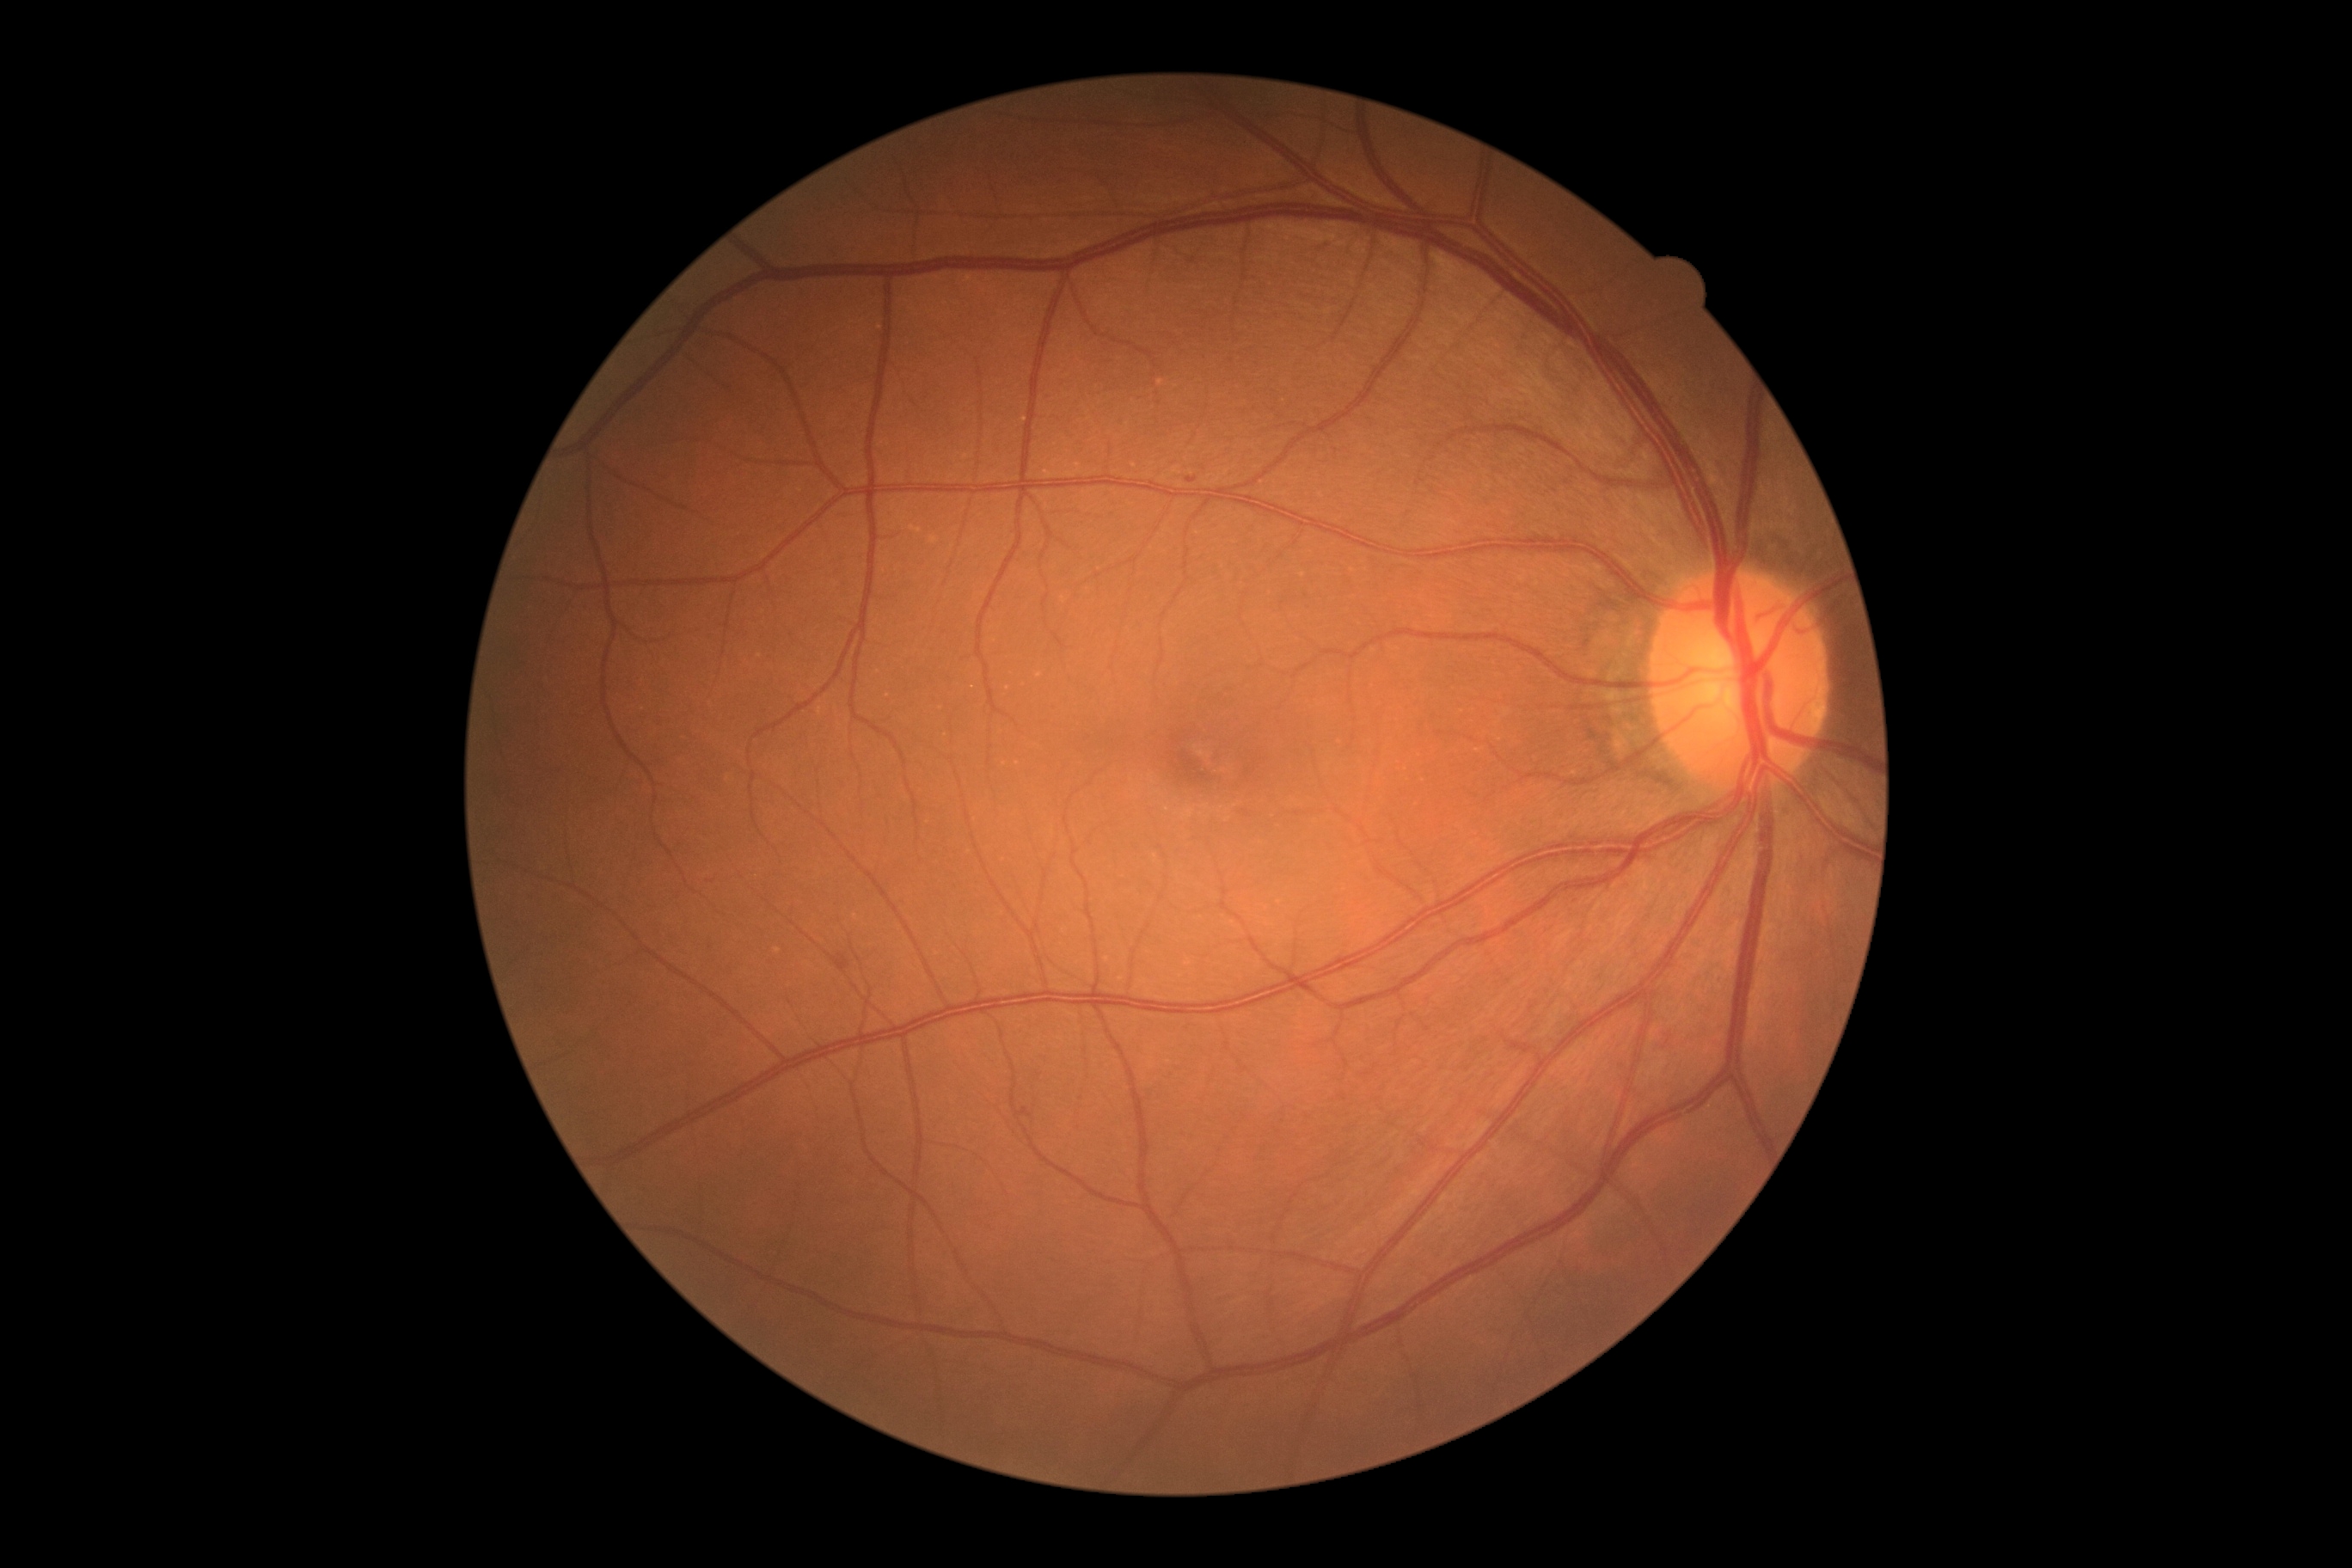

Diabetic retinopathy (DR) is 1/4.